No pharmacologic dilation · 45-degree field of view · color fundus photograph
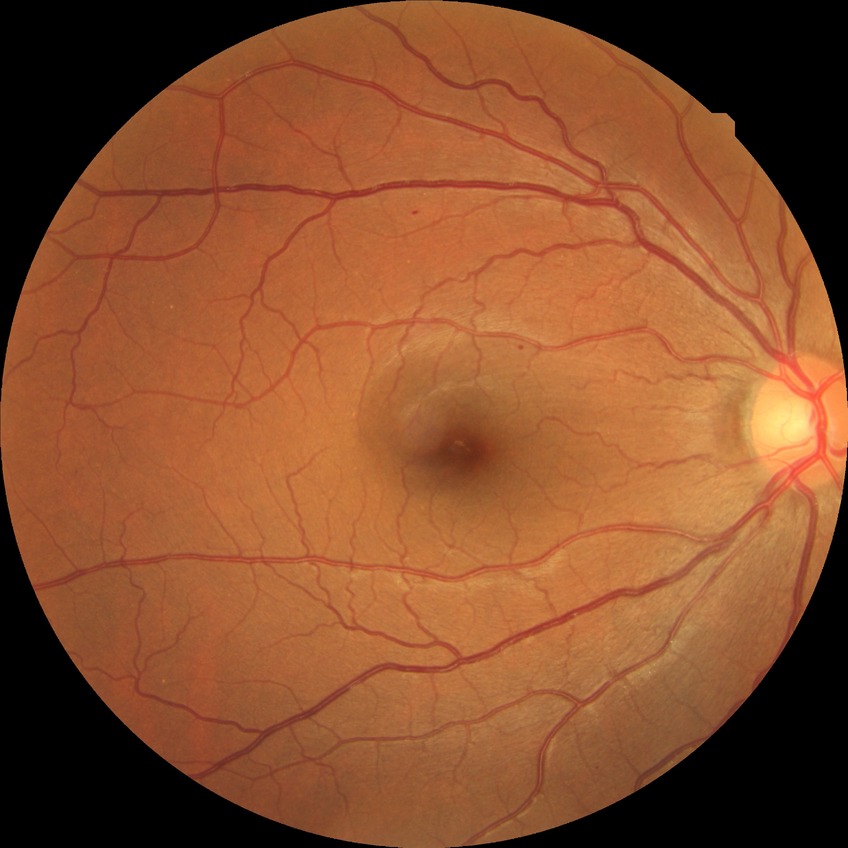

davis_grade: simple diabetic retinopathy